45 degree fundus photograph; no pharmacologic dilation — 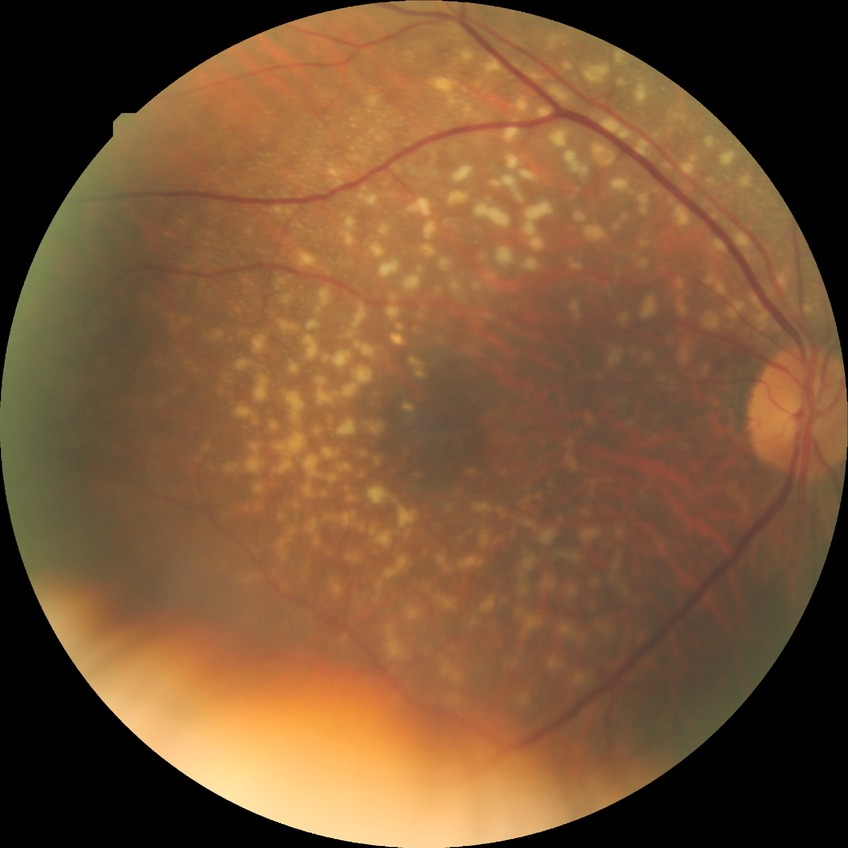 Diabetic retinopathy stage: no diabetic retinopathy.